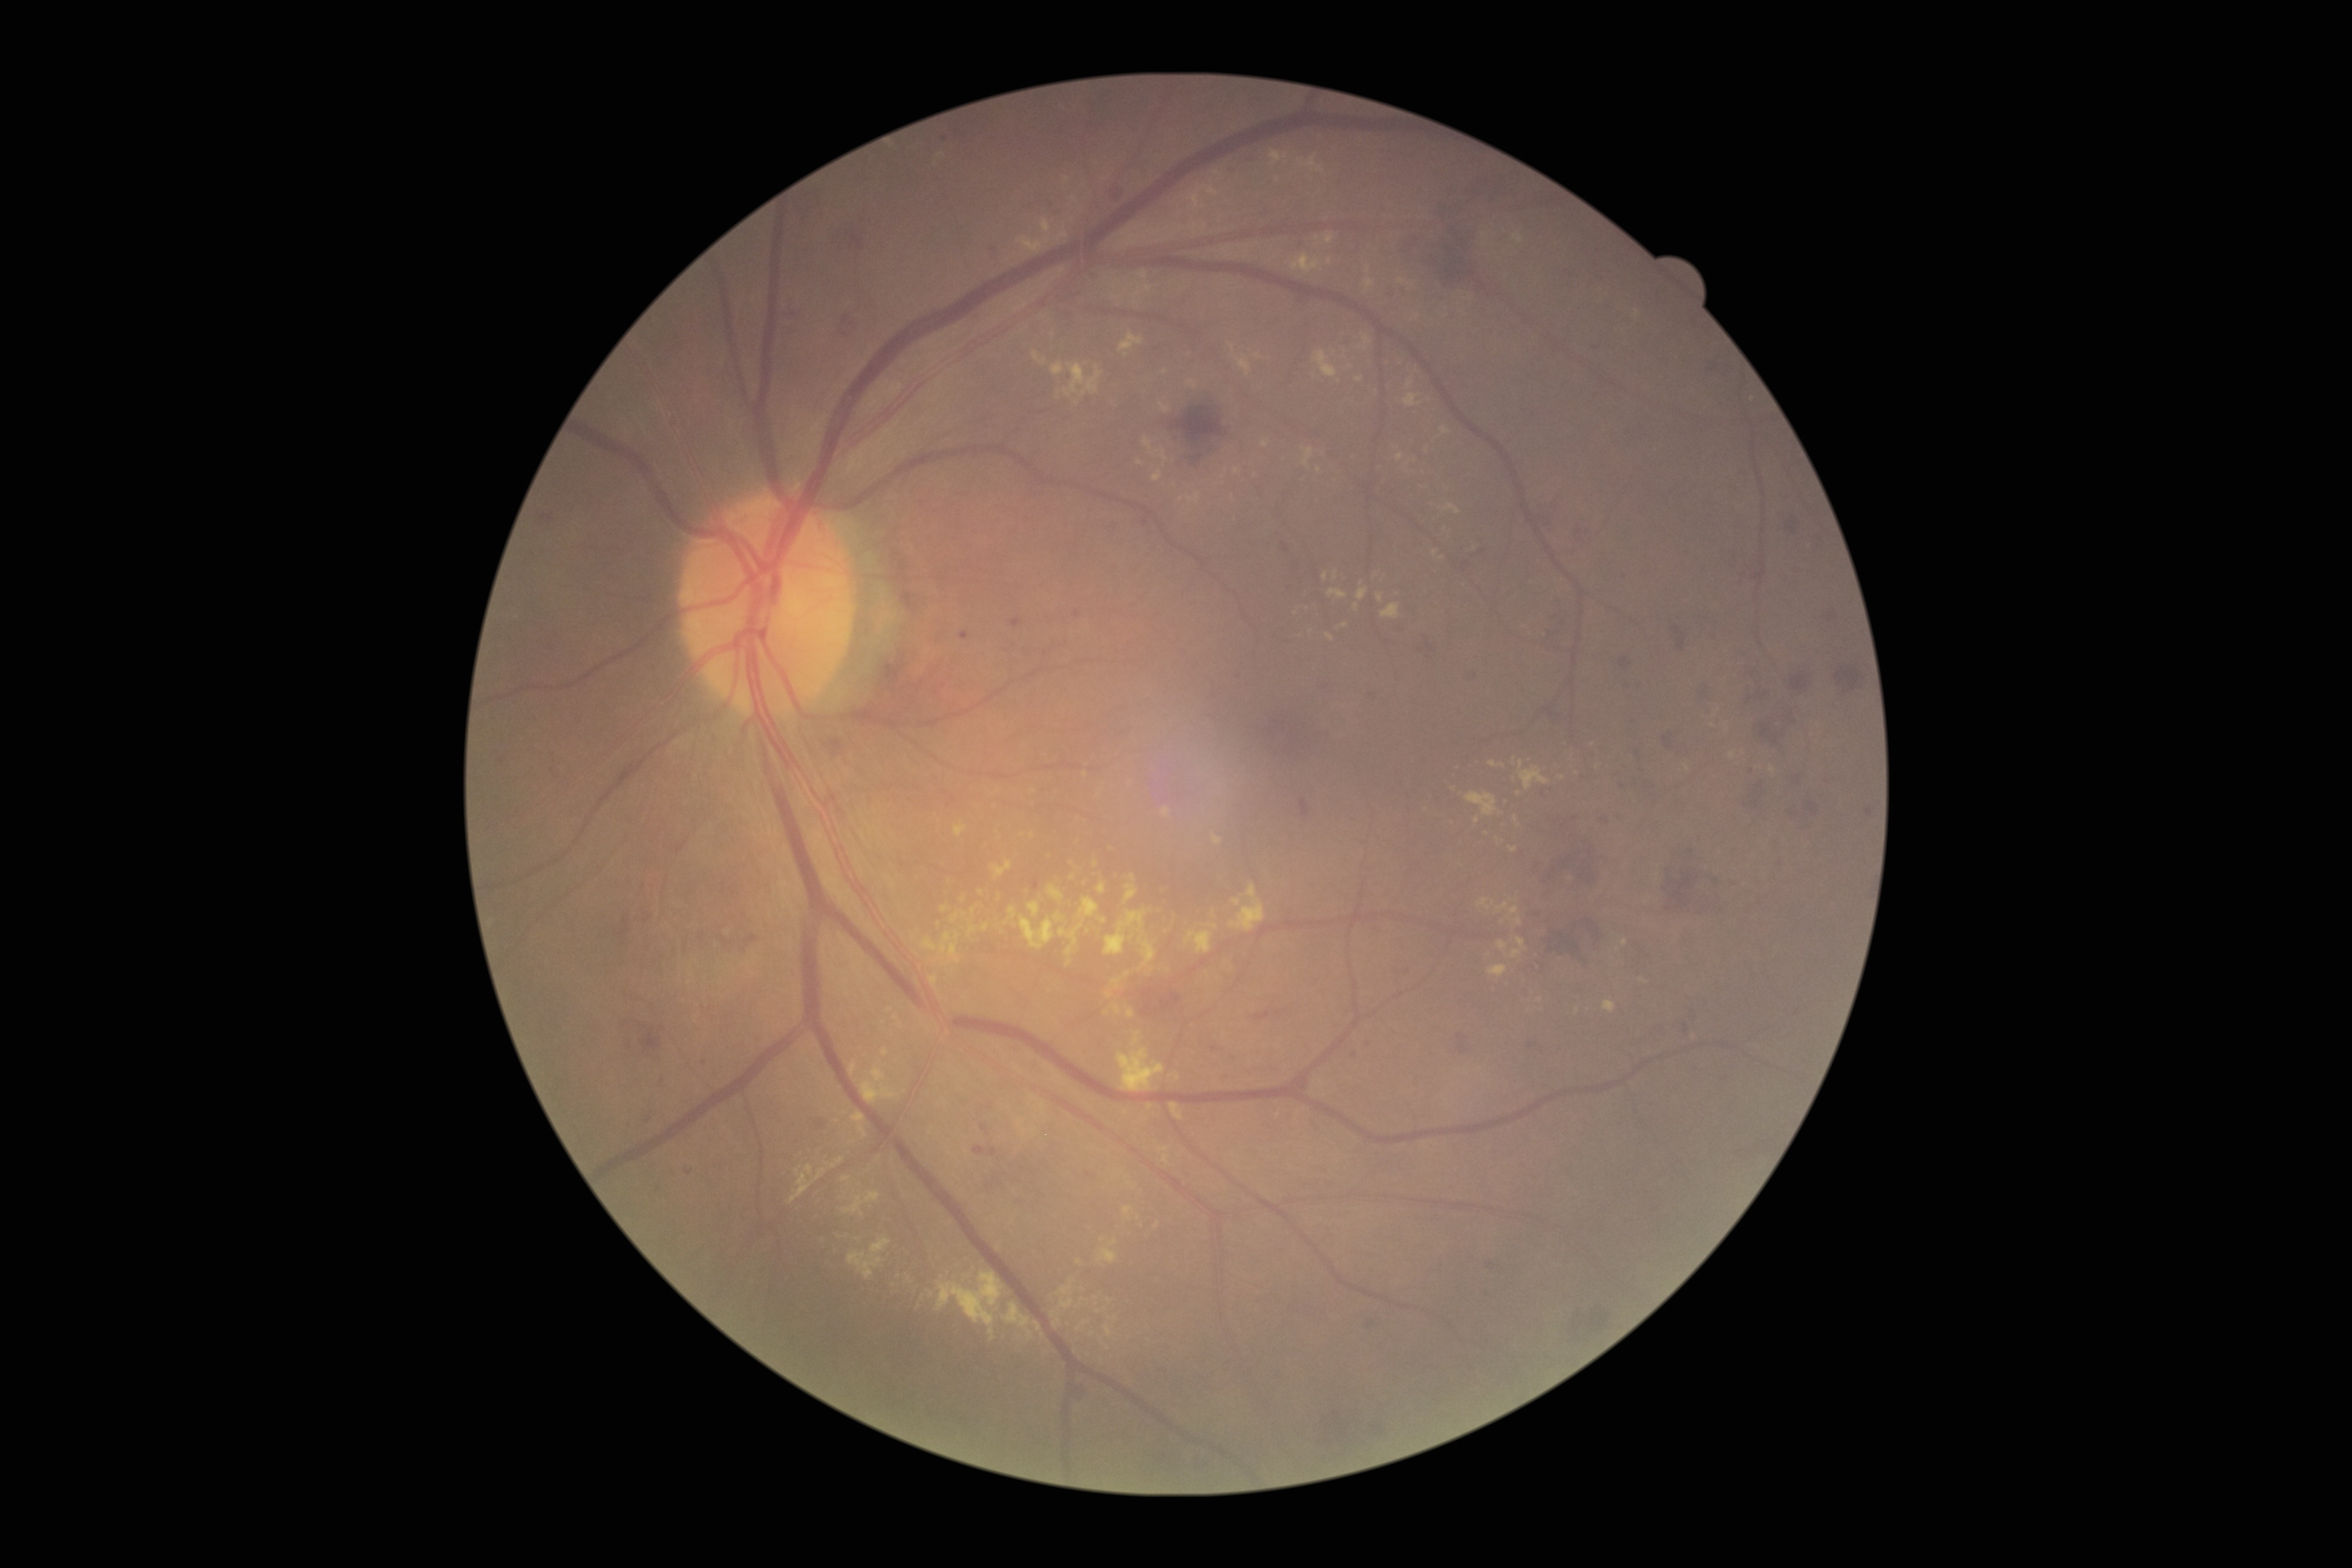

partial: true
dr_grade: 2
lesions:
  ex:
    - 1206 186 1219 197
    - 1187 494 1200 504
    - 1109 1238 1117 1247
    - 1488 965 1507 978
    - 1230 885 1265 932
    - 851 1111 868 1138
    - 866 1191 880 1203
    - 841 1175 851 1181
    - 1106 991 1112 999
    - 1520 766 1550 789
    - 969 925 977 936
  ex_small_centers:
    - (1074; 200)
    - (1085; 774)
    - (1411; 285)
    - (1500; 837)
    - (1296; 613)
    - (1477; 820)
    - (1519; 793)